Wide-field contact fundus photograph of an infant:
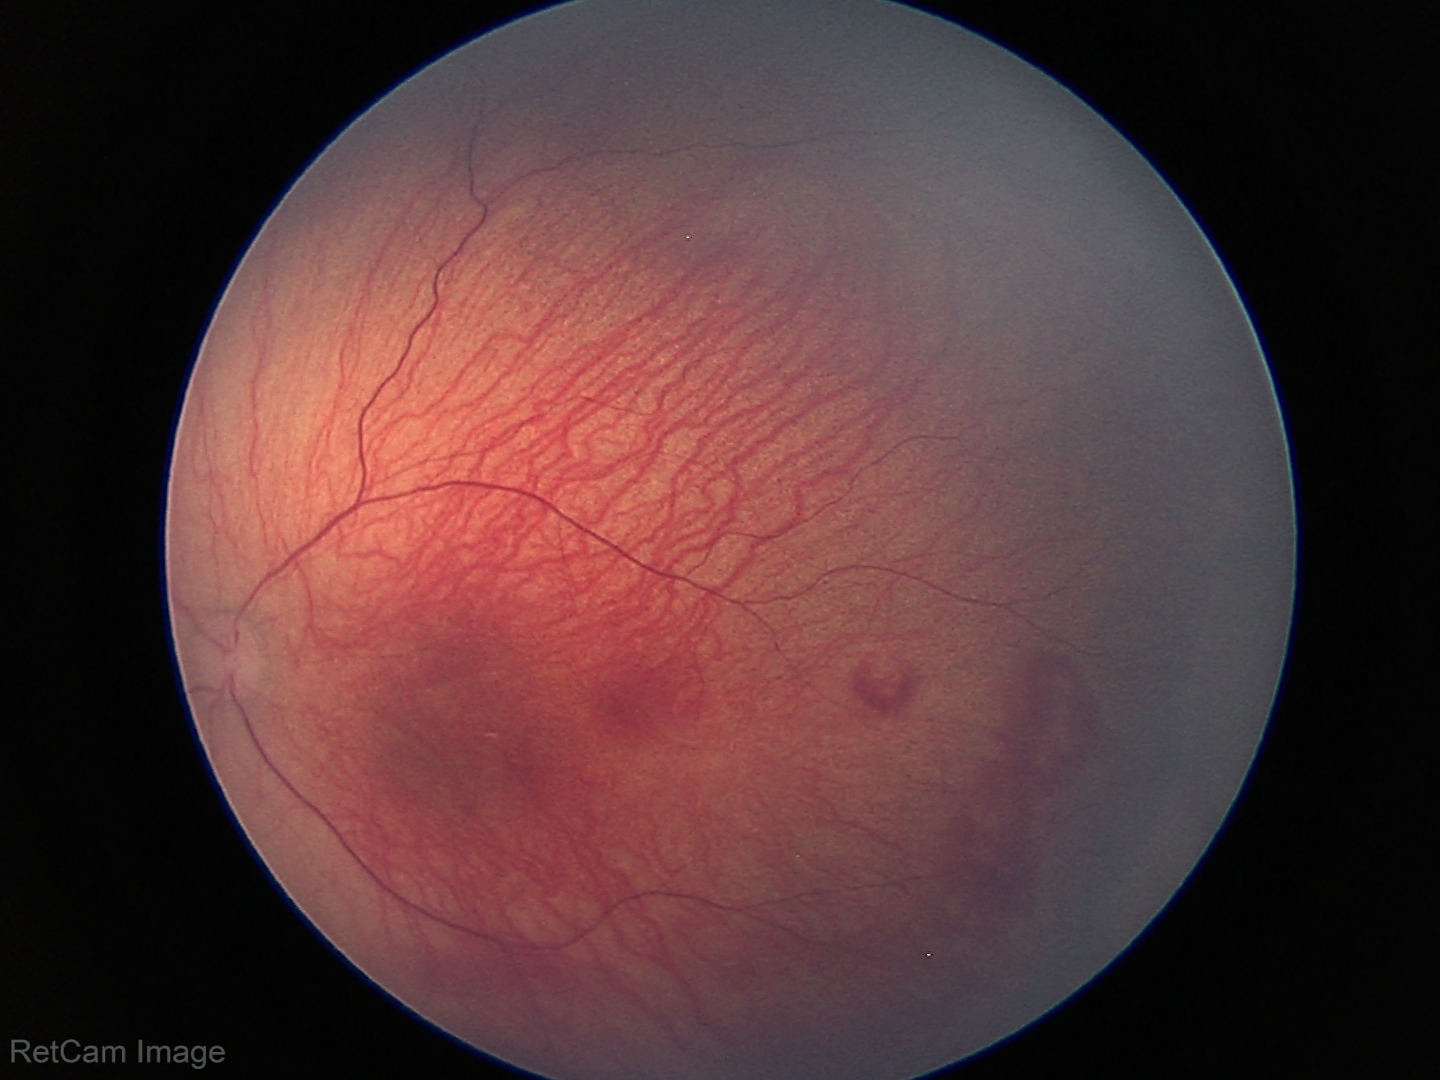
Q: Plus disease status?
A: no plus disease
Q: What is the diagnosis from this examination?
A: ROP stage 1